CFP · 512 by 512 pixels — 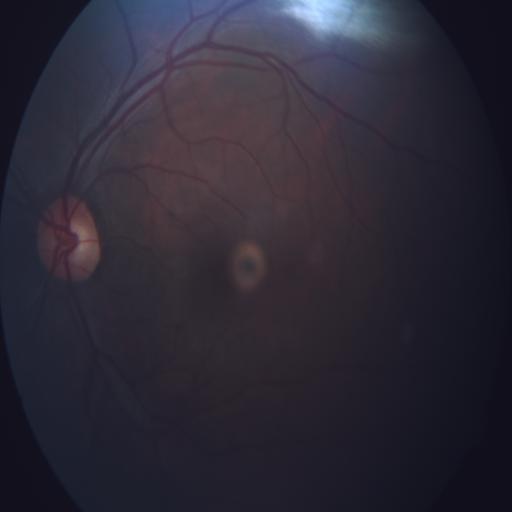
Within normal limits. No abnormalities identified.